Modified Davis grading. 848x848px. NIDEK AFC-230 fundus camera. CFP. Without pupil dilation. 45 degree fundus photograph
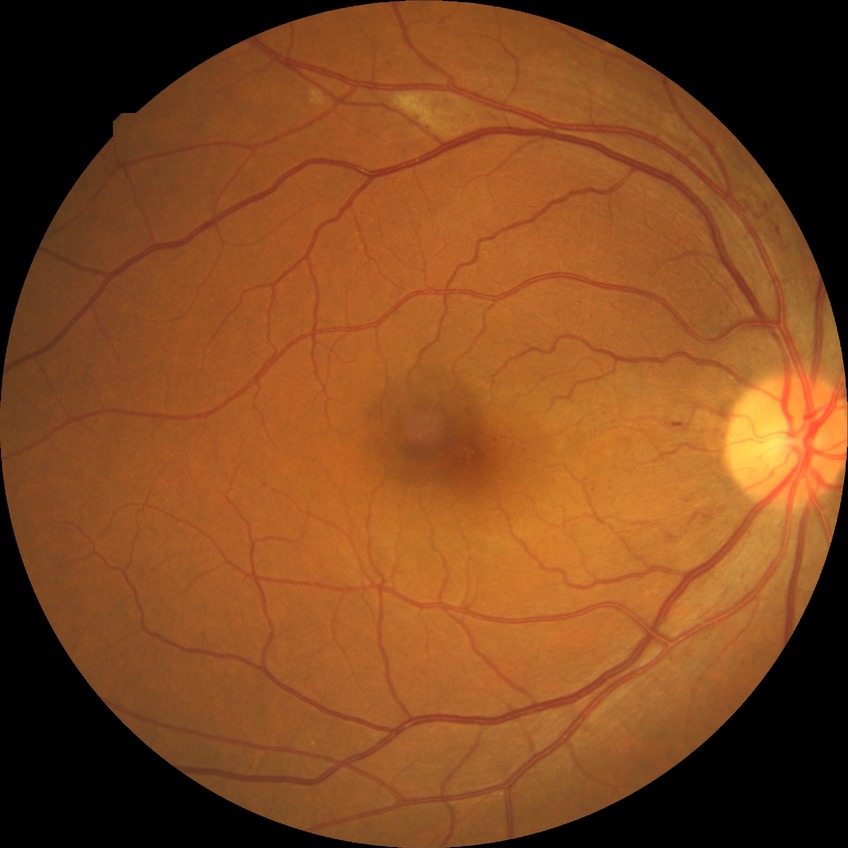
modified Davis classification = pre-proliferative diabetic retinopathy